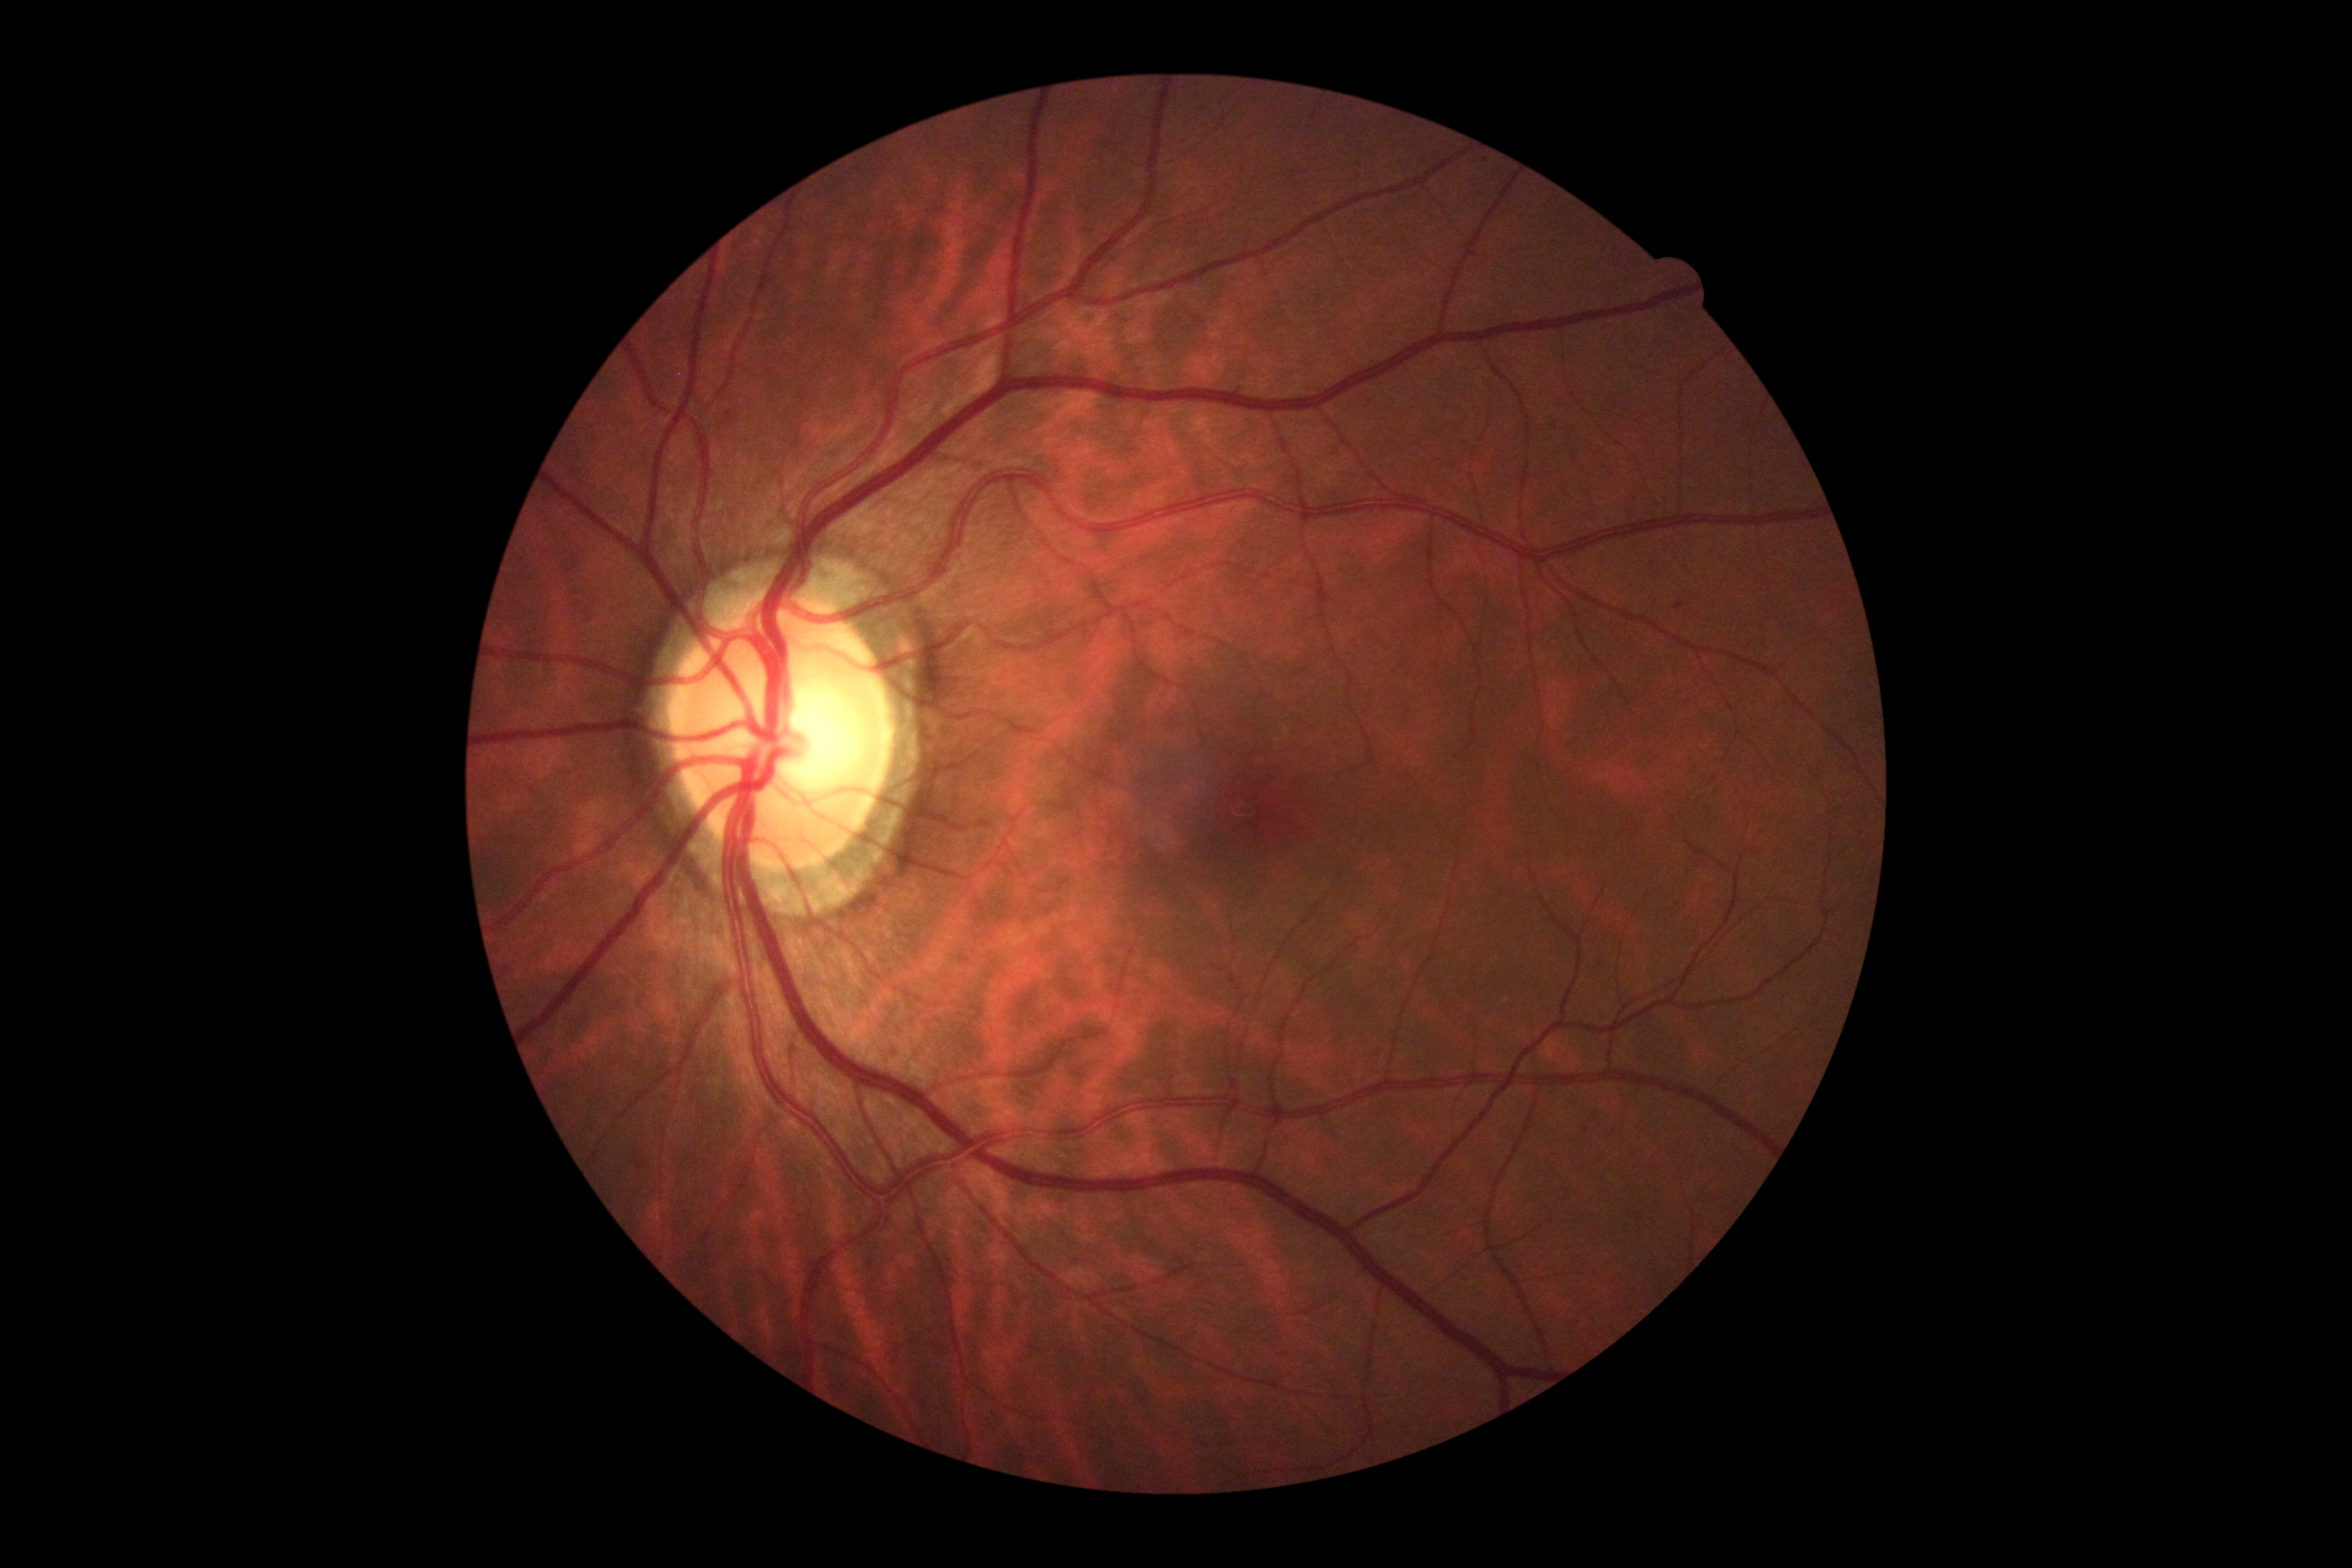 diabetic retinopathy severity: 0.